Phoenix ICON, 100° FOV. 1240 x 1240 pixels. Pediatric wide-field fundus photograph: 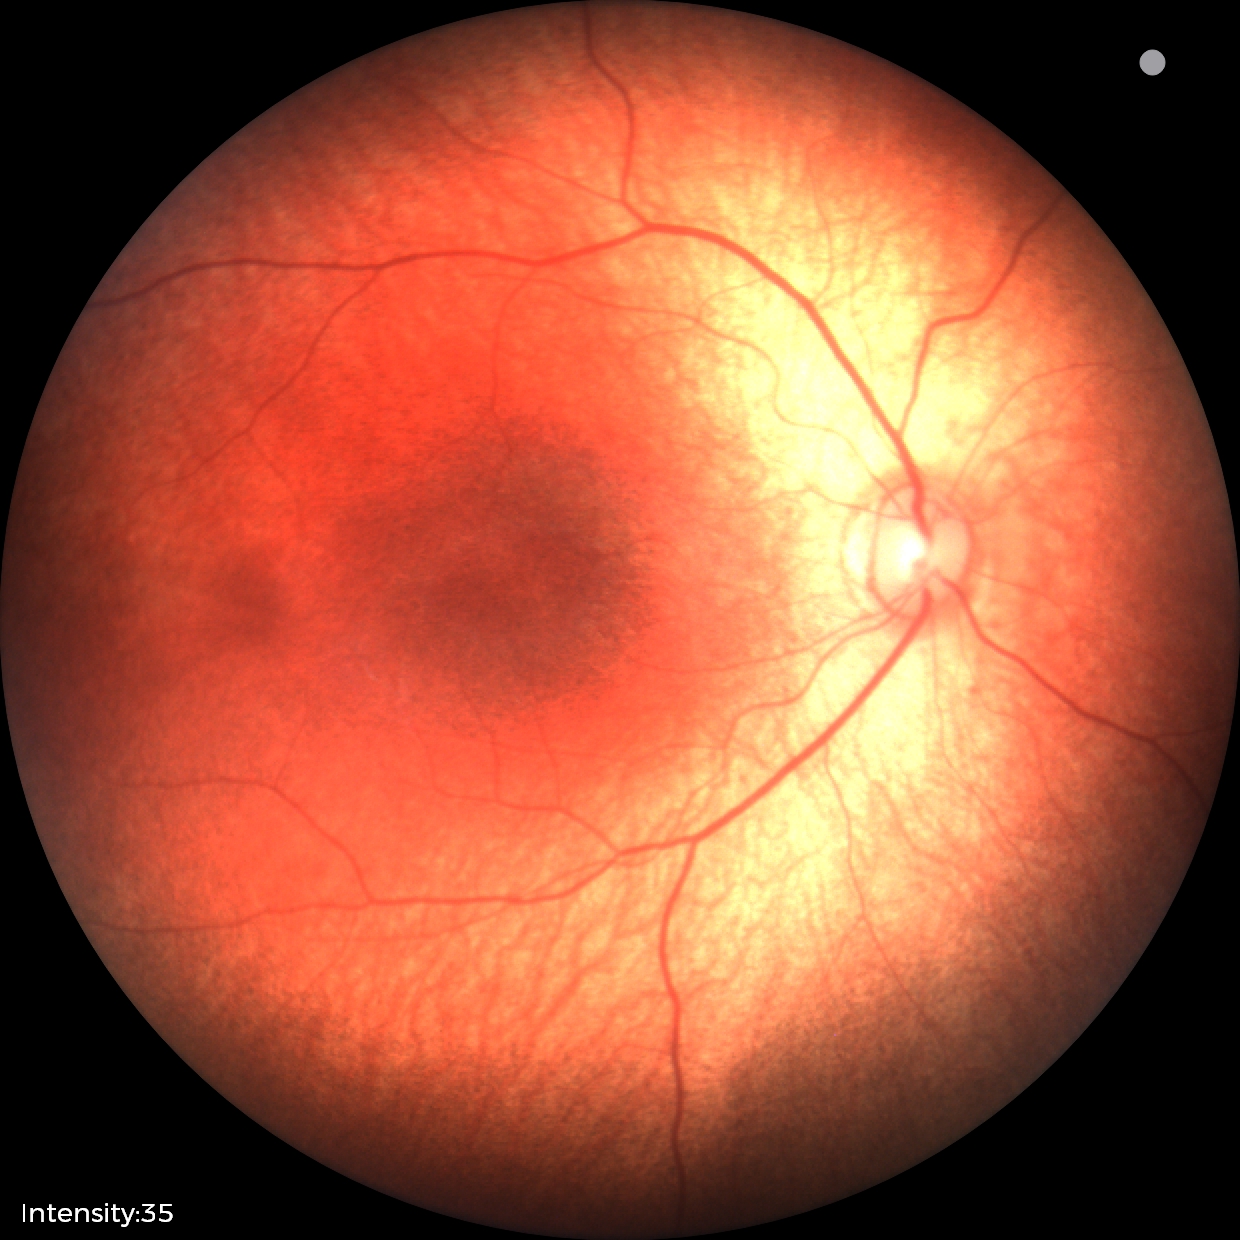 Physiological retinal appearance for postconceptual age.